Diabetic retinopathy graded by the modified Davis classification — 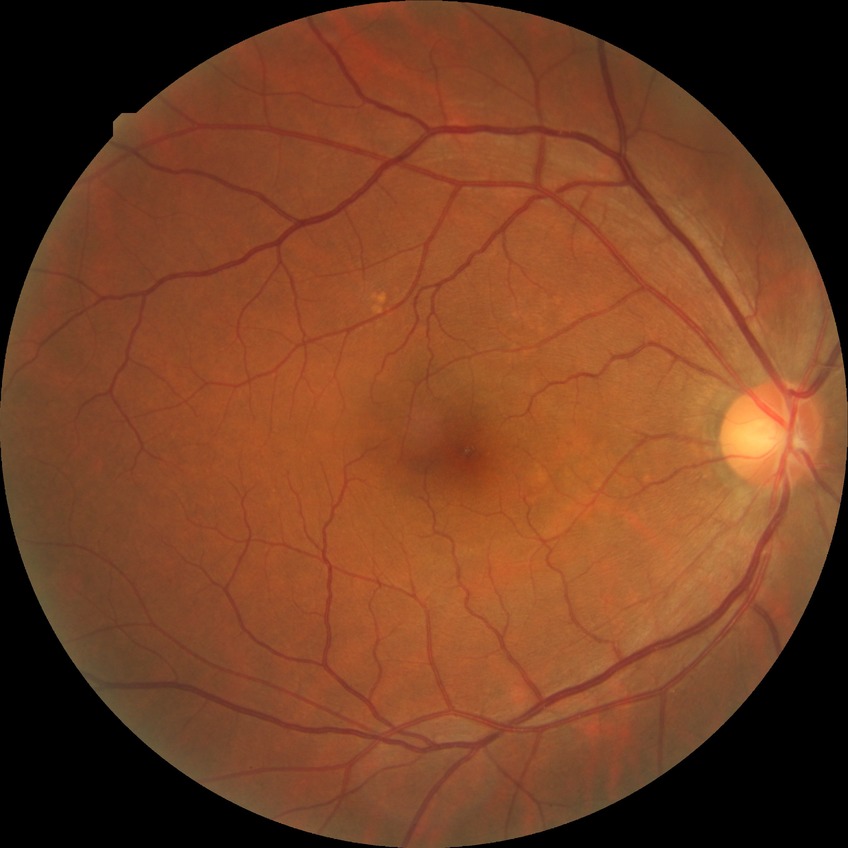 diabetic retinopathy (DR)@no diabetic retinopathy (NDR).